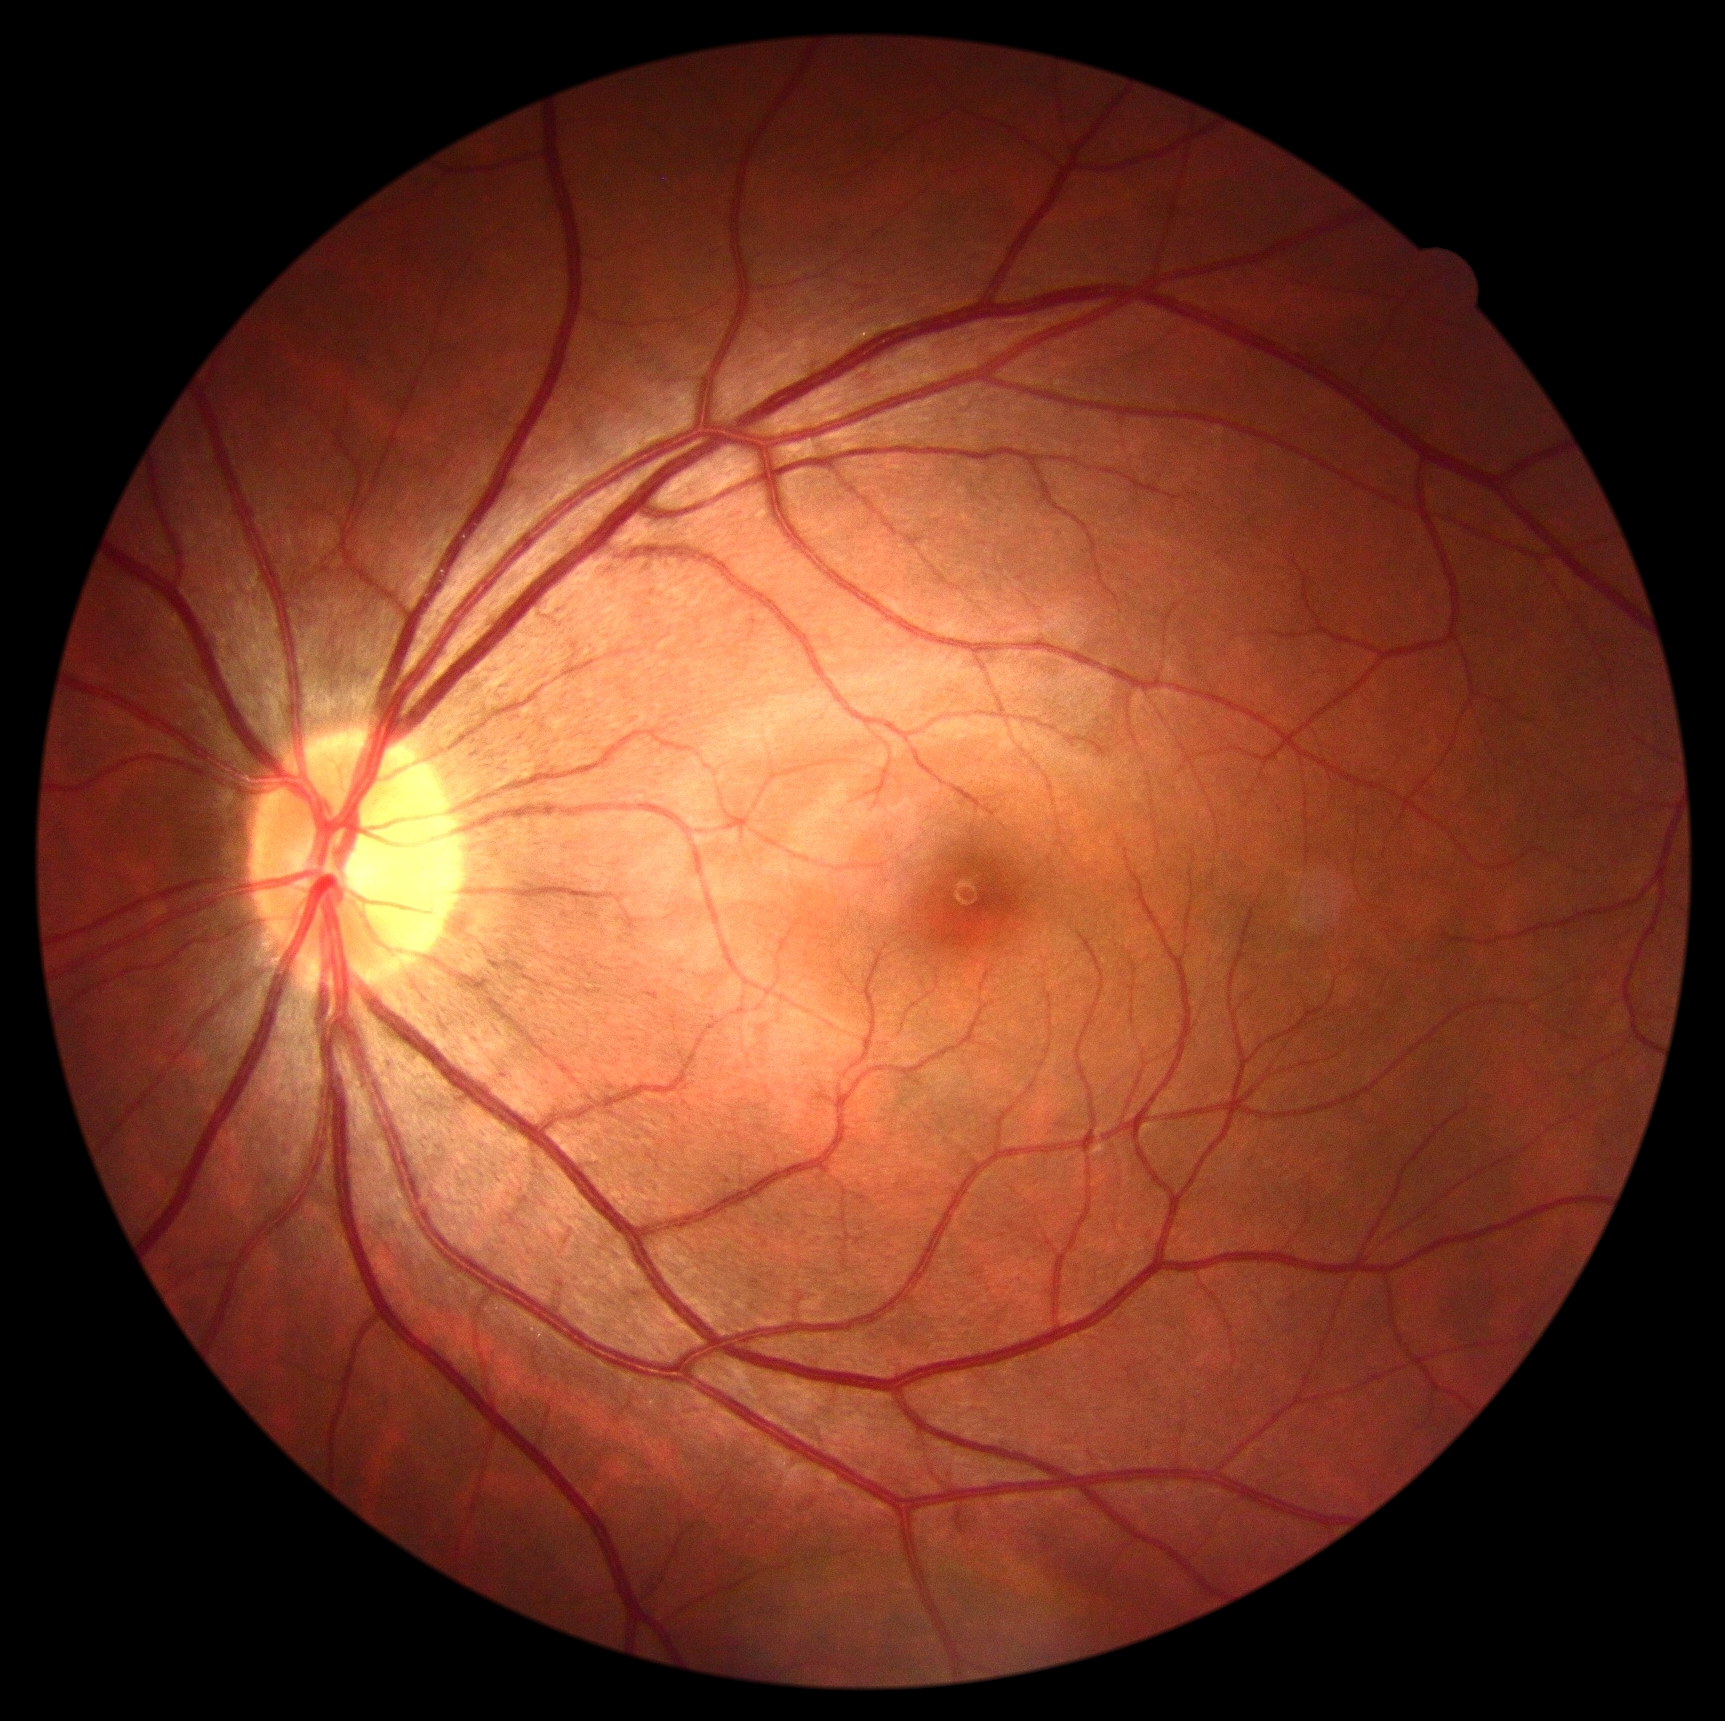 Retinopathy grade: no apparent retinopathy (0).